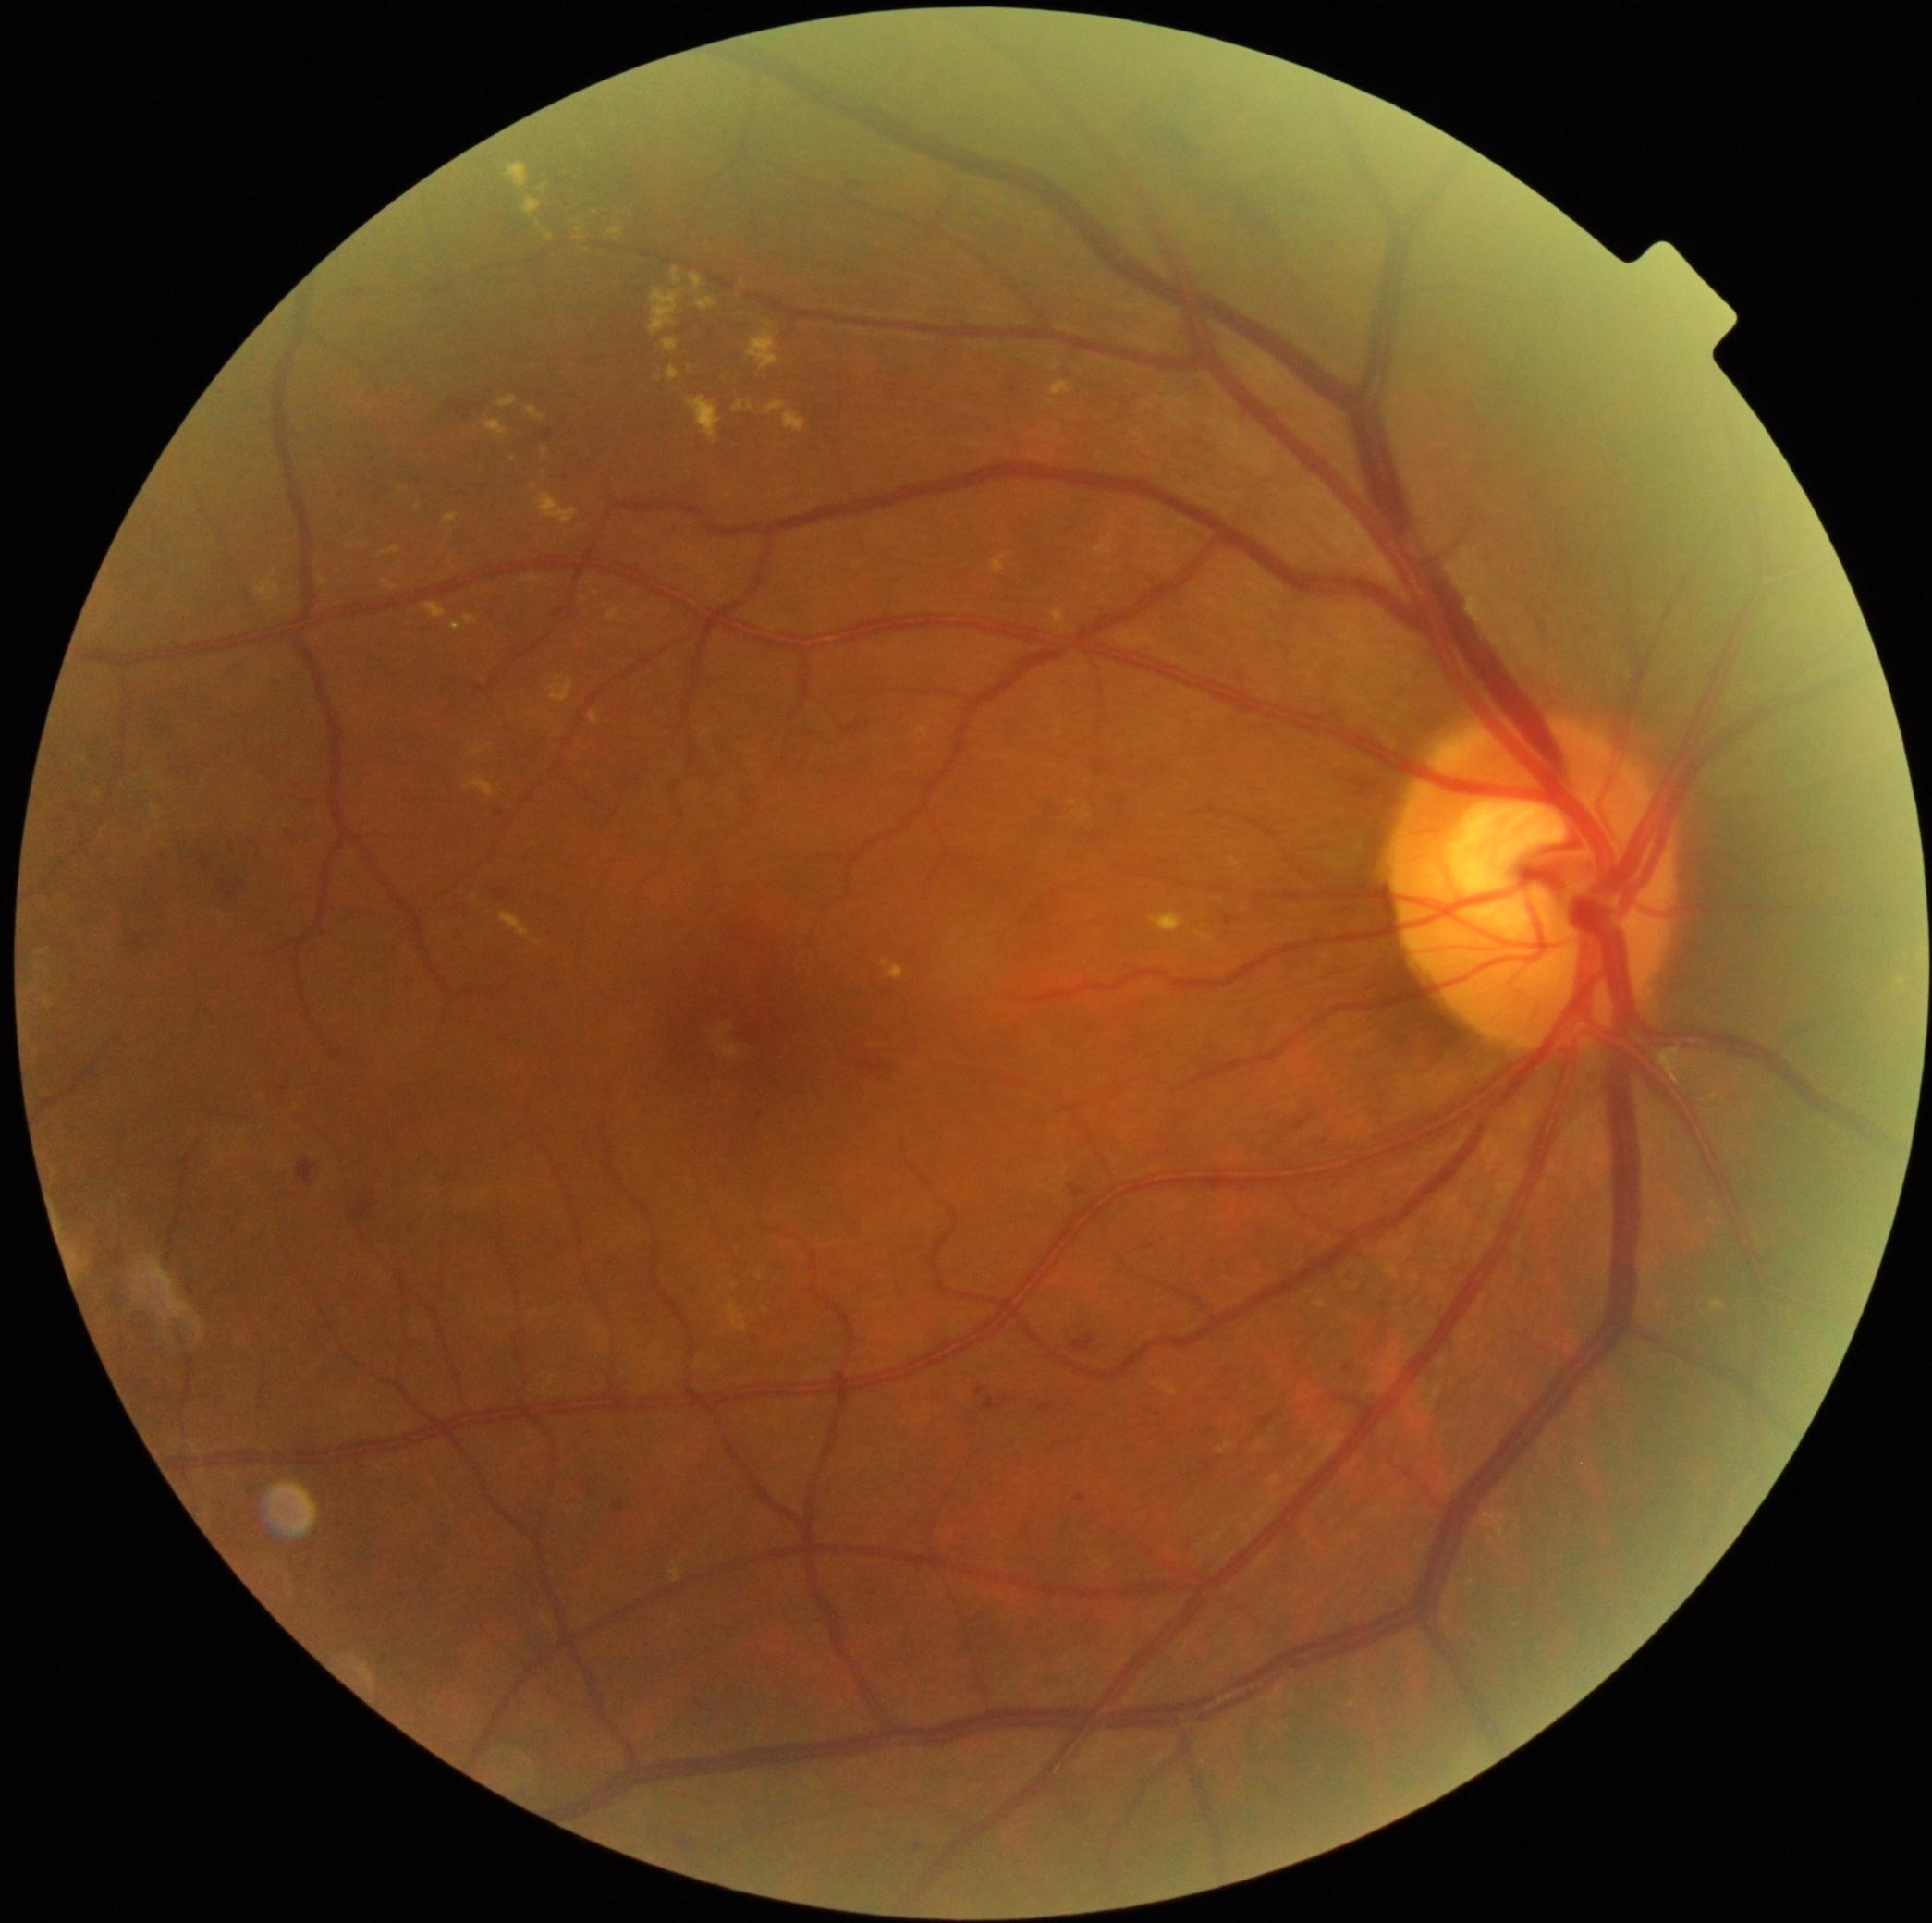 partial: true
dr_grade: 2
lesions:
  ex:
    - [748, 325, 781, 372]
    - [381, 547, 399, 557]
    - [1156, 1380, 1178, 1397]
    - [94, 790, 102, 798]
    - [319, 577, 328, 586]
    - [452, 622, 463, 633]
    - [465, 776, 495, 798]
    - [609, 226, 624, 242]
    - [663, 339, 679, 353]
    - [785, 412, 807, 434]
    - [592, 209, 600, 214]
    - [1194, 931, 1216, 944]
  ex_small_centers:
    - <pt>545,187</pt>
    - <pt>597,595</pt>
    - <pt>532,591</pt>
    - <pt>1903,983</pt>
    - <pt>761,1278</pt>
    - <pt>608,169</pt>